45° FOV. 2212x1659px
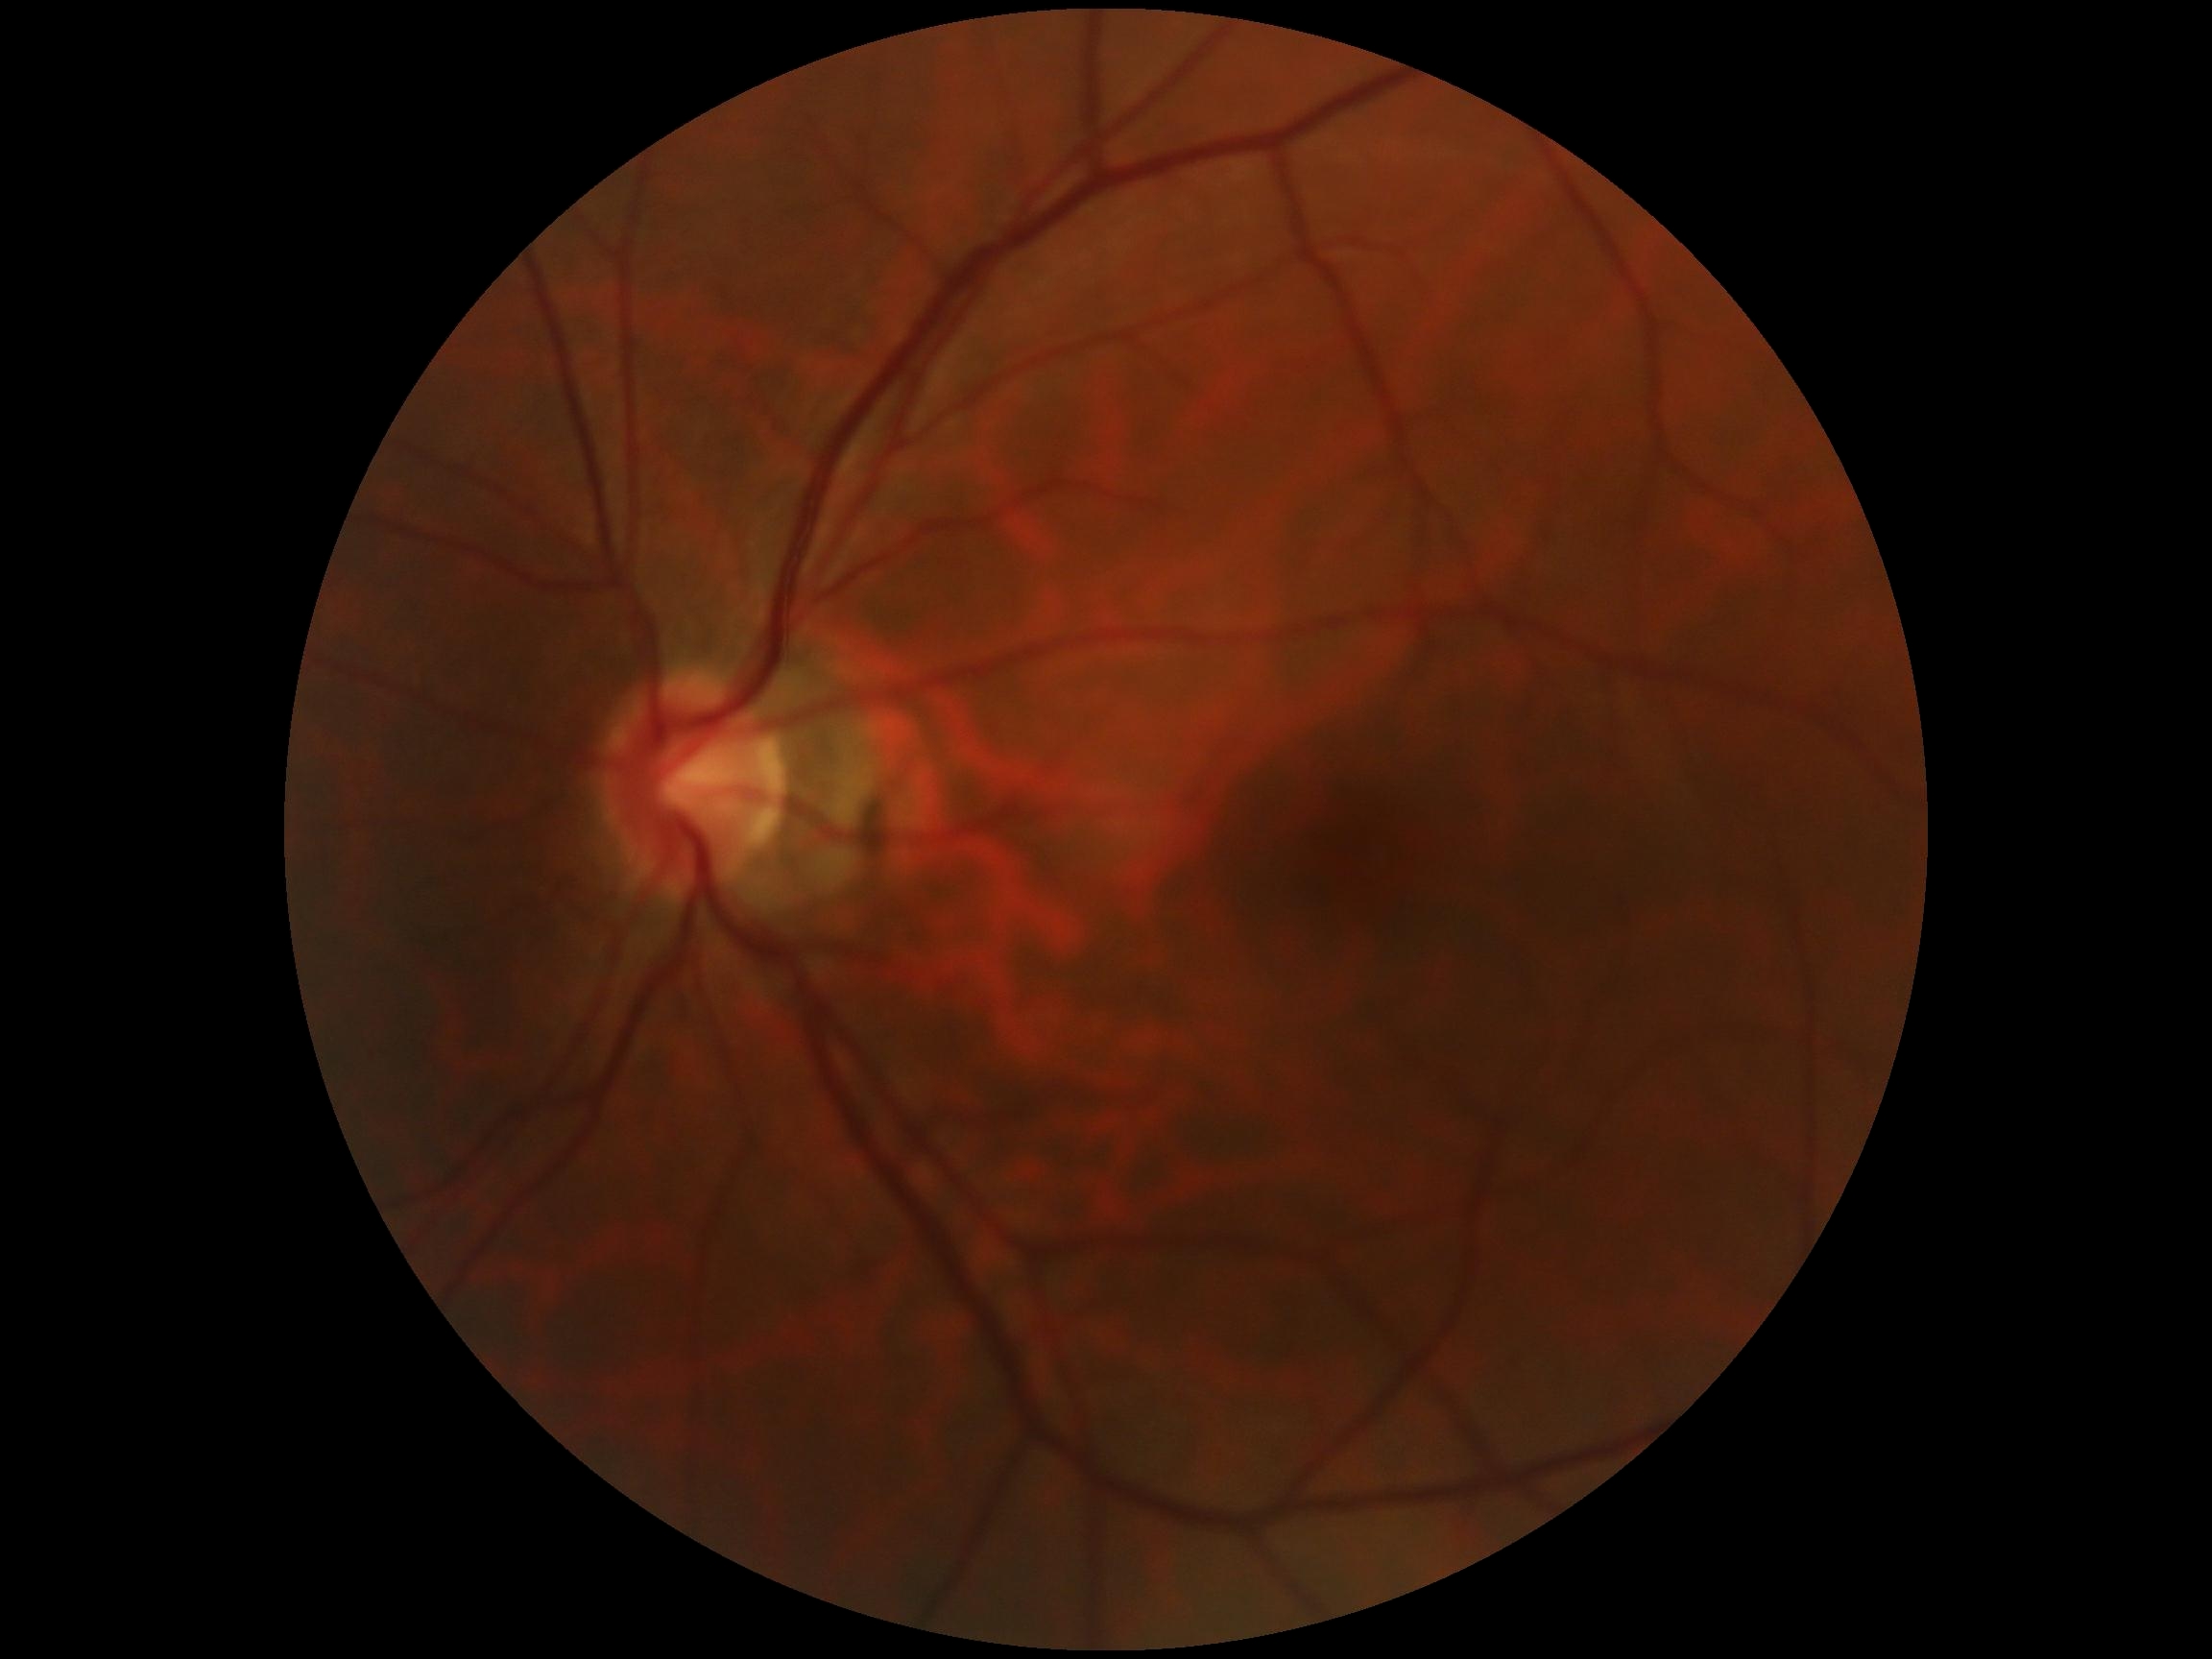
DR grade: 0.
No diabetic retinal disease findings.